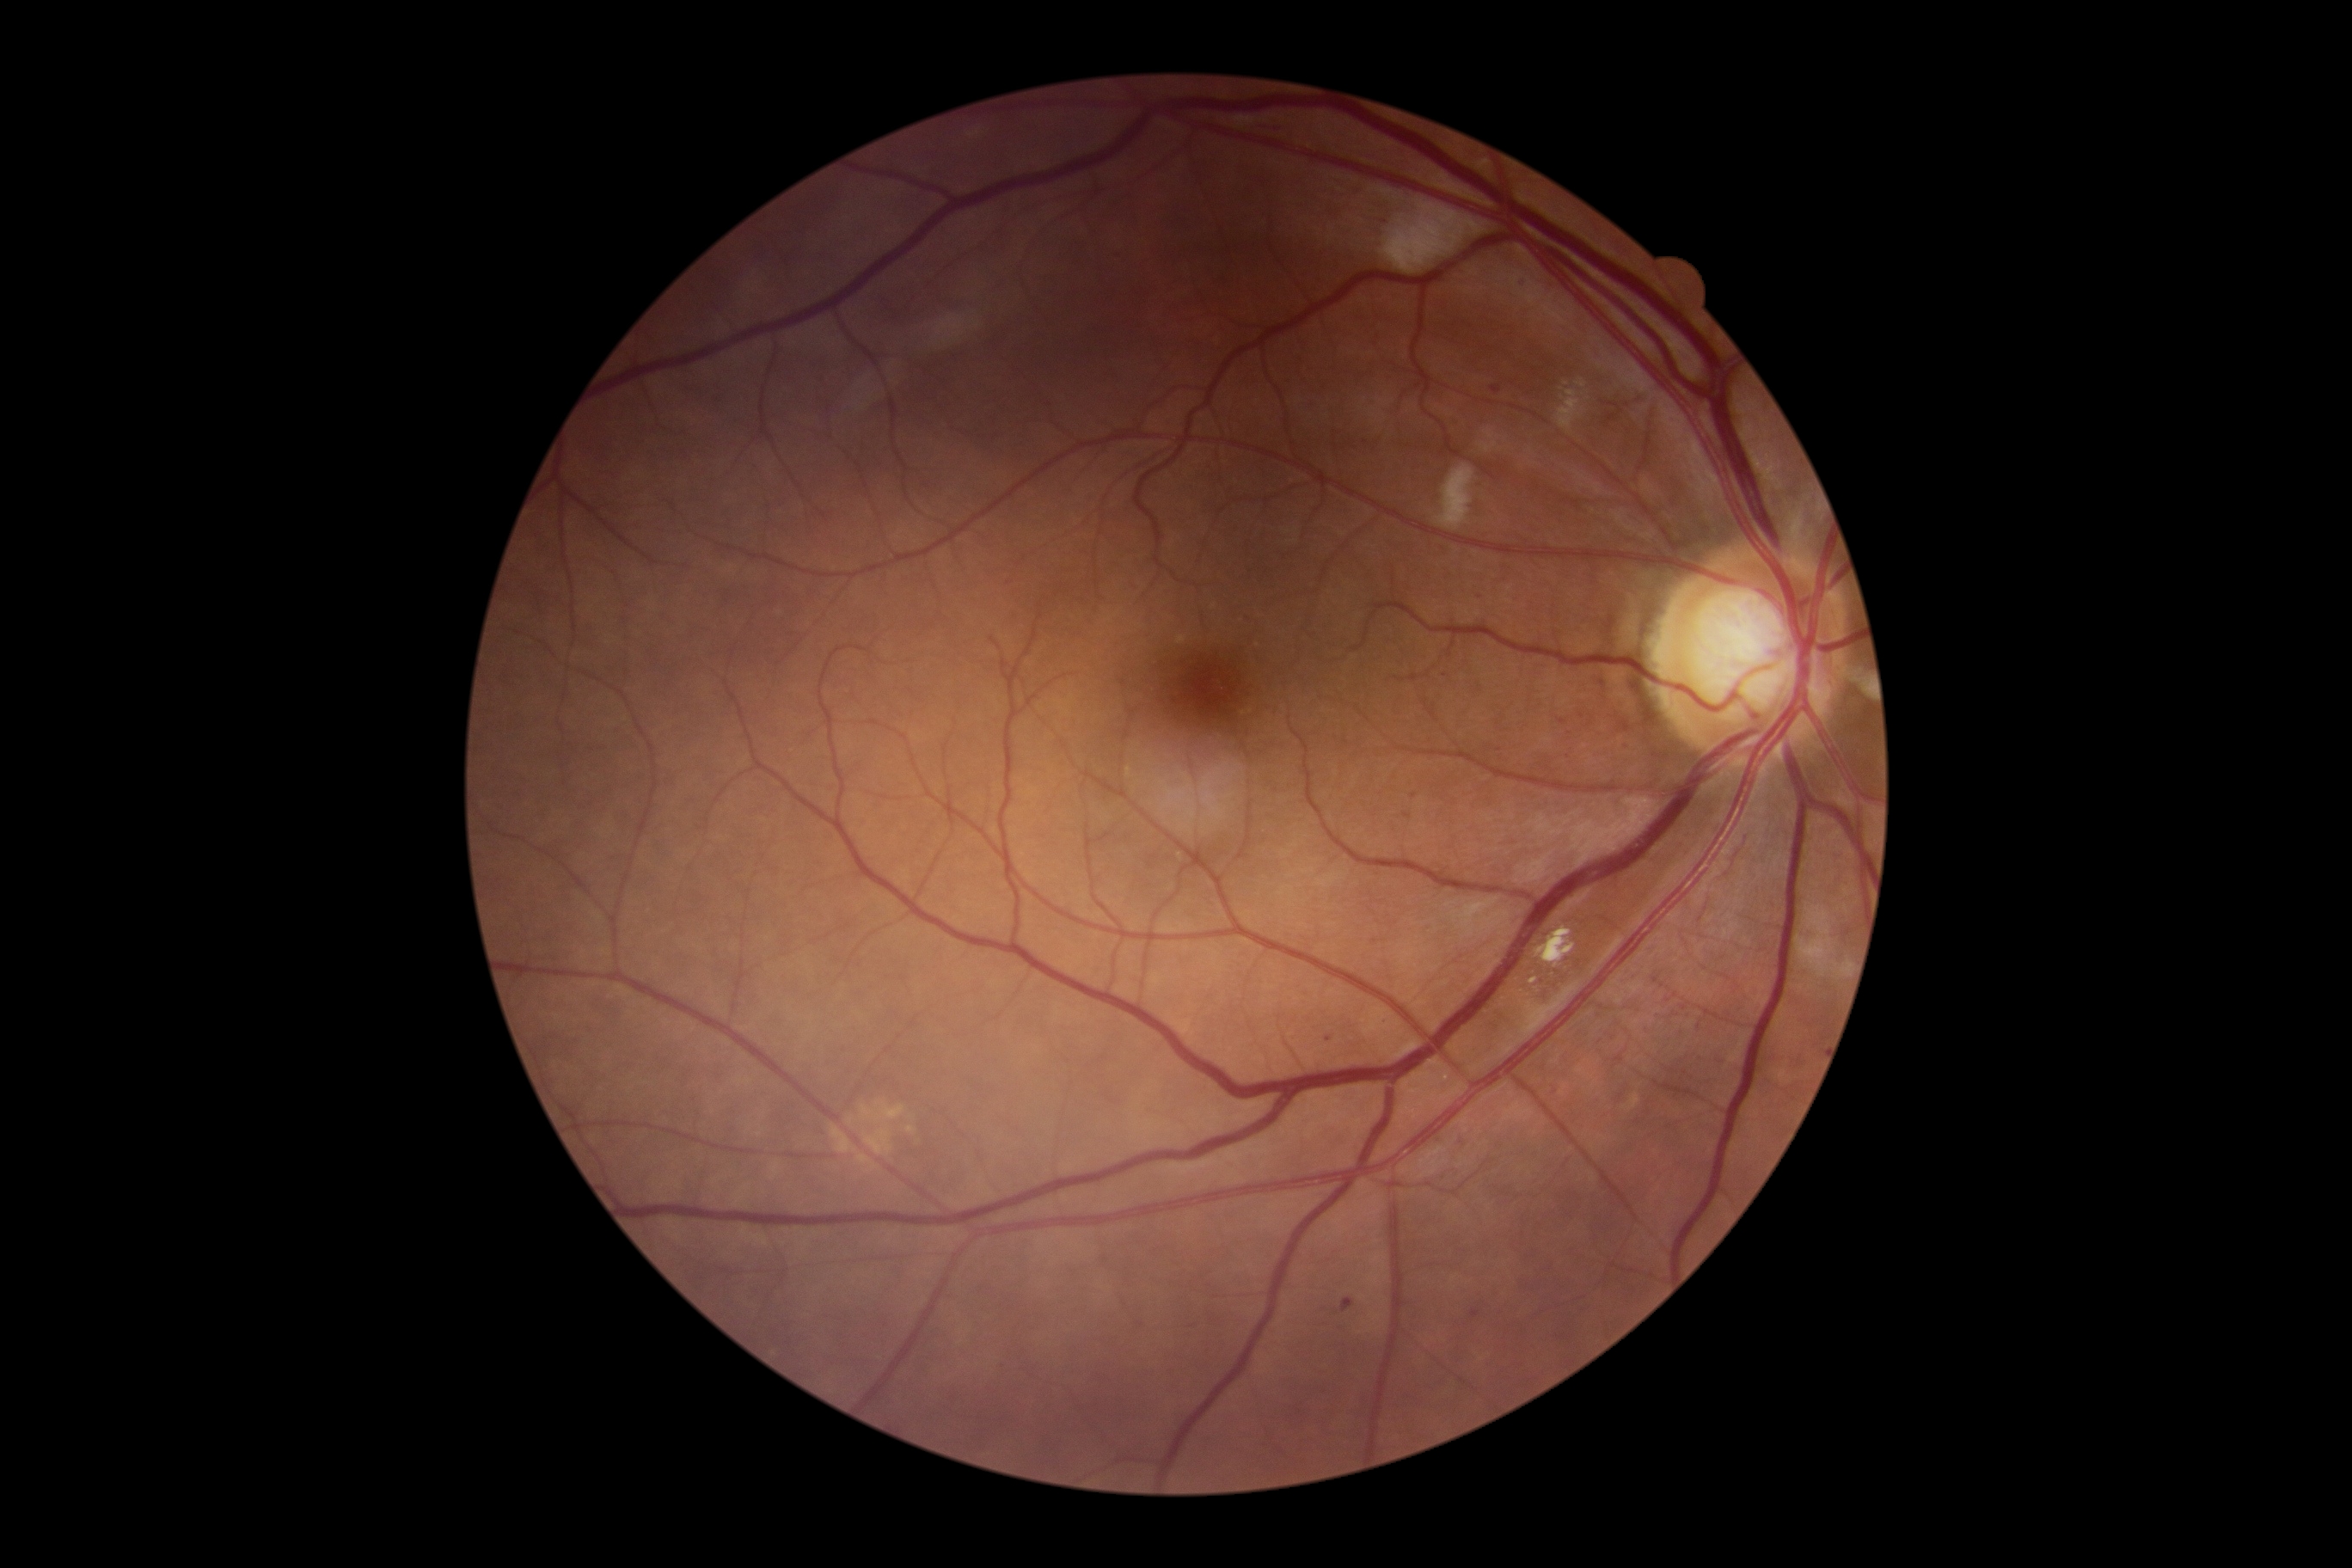

DR severity is moderate non-proliferative diabetic retinopathy (grade 2); non-proliferative diabetic retinopathy. MAs (partial list) at rect(1342, 1299, 1354, 1313); rect(1614, 1055, 1624, 1063); rect(1681, 1003, 1689, 1012); rect(1471, 1311, 1481, 1320); rect(1491, 386, 1502, 393). Small MAs approximately at (1445; 676); (1668; 1001); (1562; 722); (1699; 1028); (1329; 1039); (1415; 796); (1522; 279). EXs located at rect(1536, 928, 1576, 967). Small EXs approximately at (1534; 981). SEs located at rect(1381, 200, 1486, 276); rect(1557, 391, 1584, 434); rect(1435, 465, 1476, 532); rect(1796, 907, 1834, 977). No HEs identified.